Wide-field fundus image from infant ROP screening — 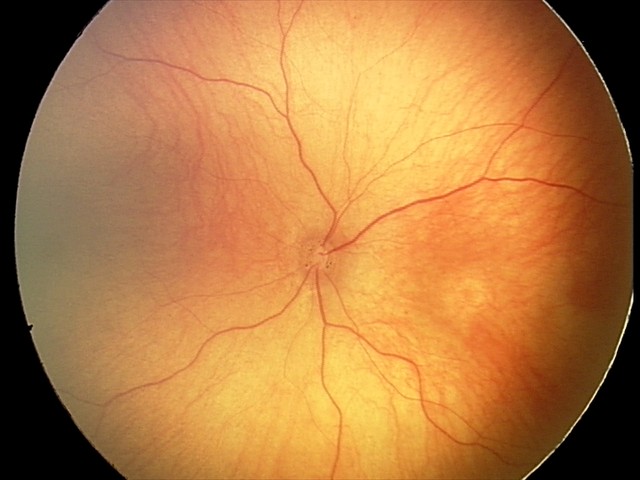 From an examination with diagnosis of optic nerve hypoplasia.